848x848px
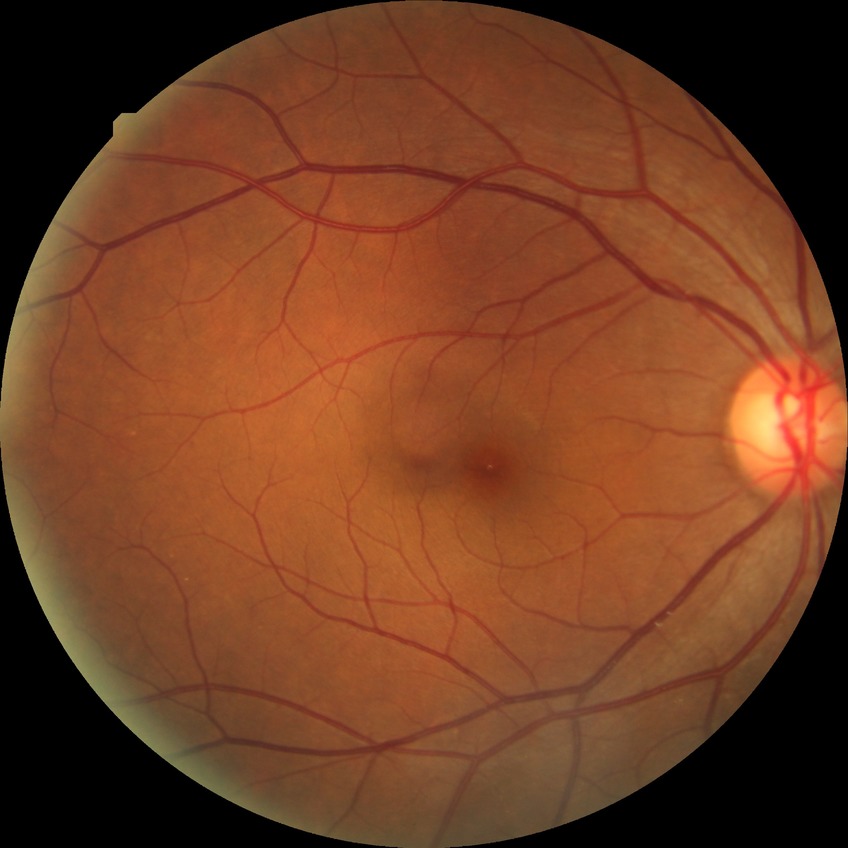

  davis_grade: no diabetic retinopathy